Image size 2089x1764
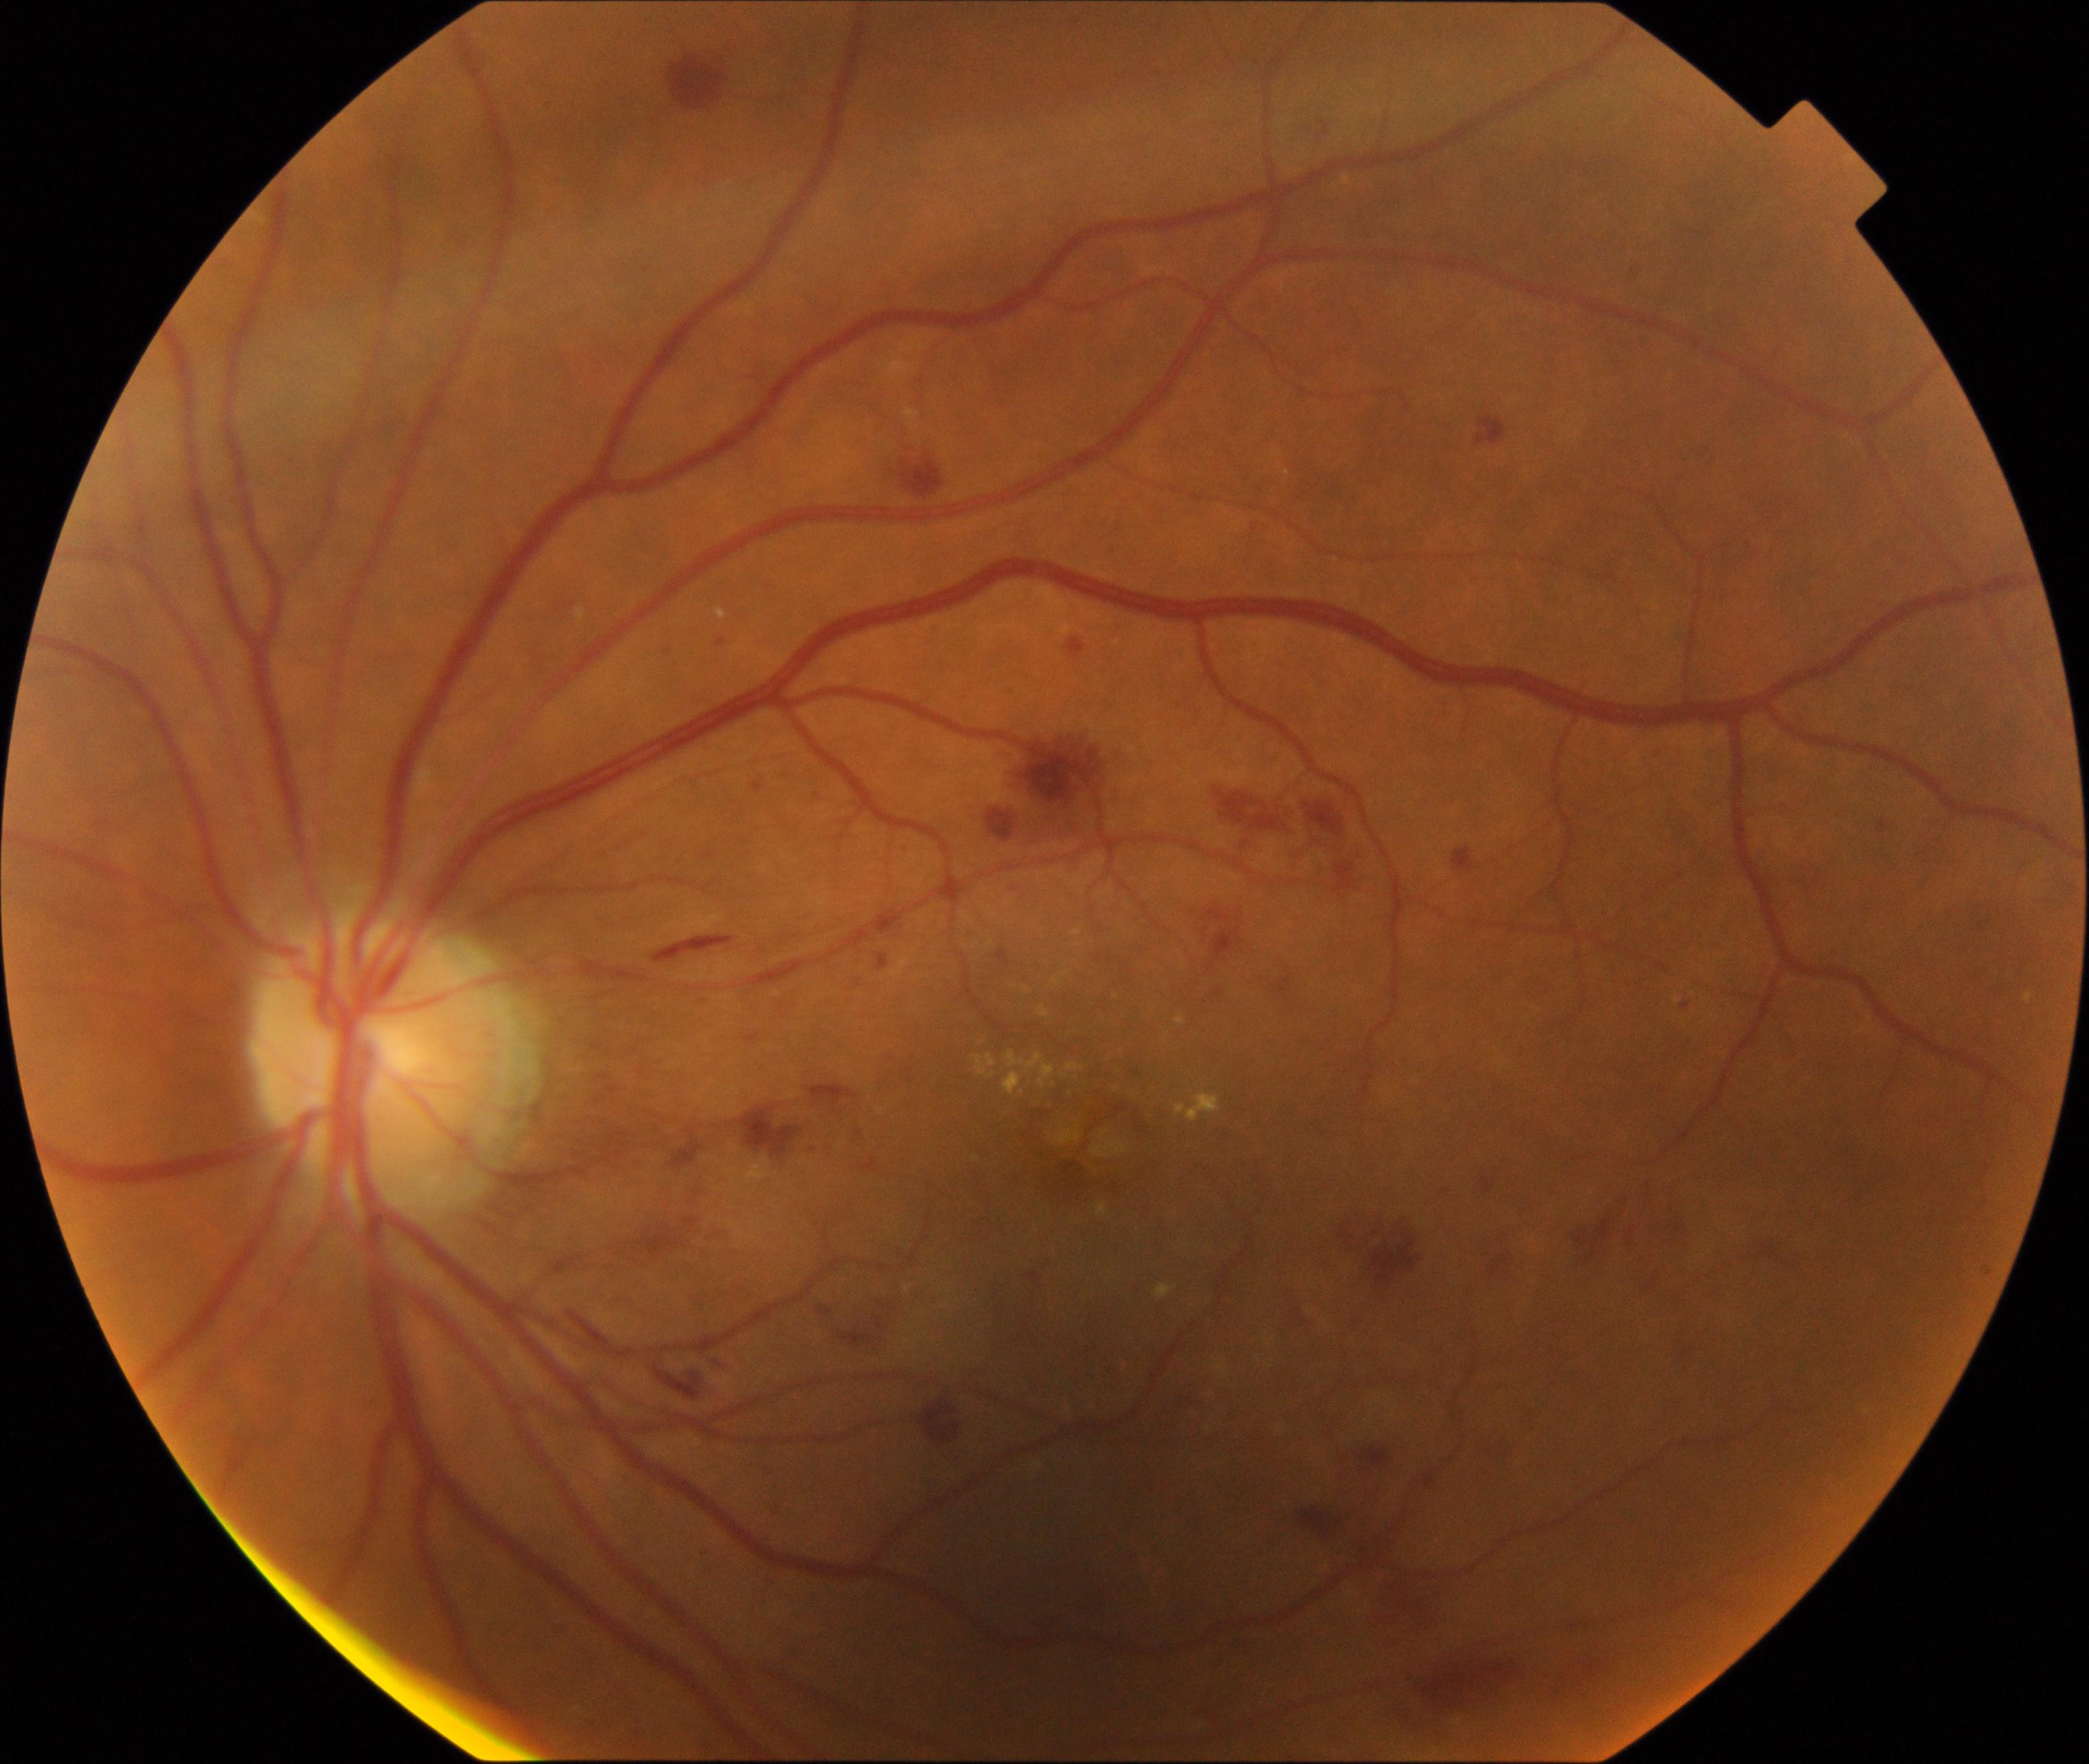

The image shows moderate non-proliferative diabetic retinopathy.